Fundus photo. 1932x1916. 45° FOV: 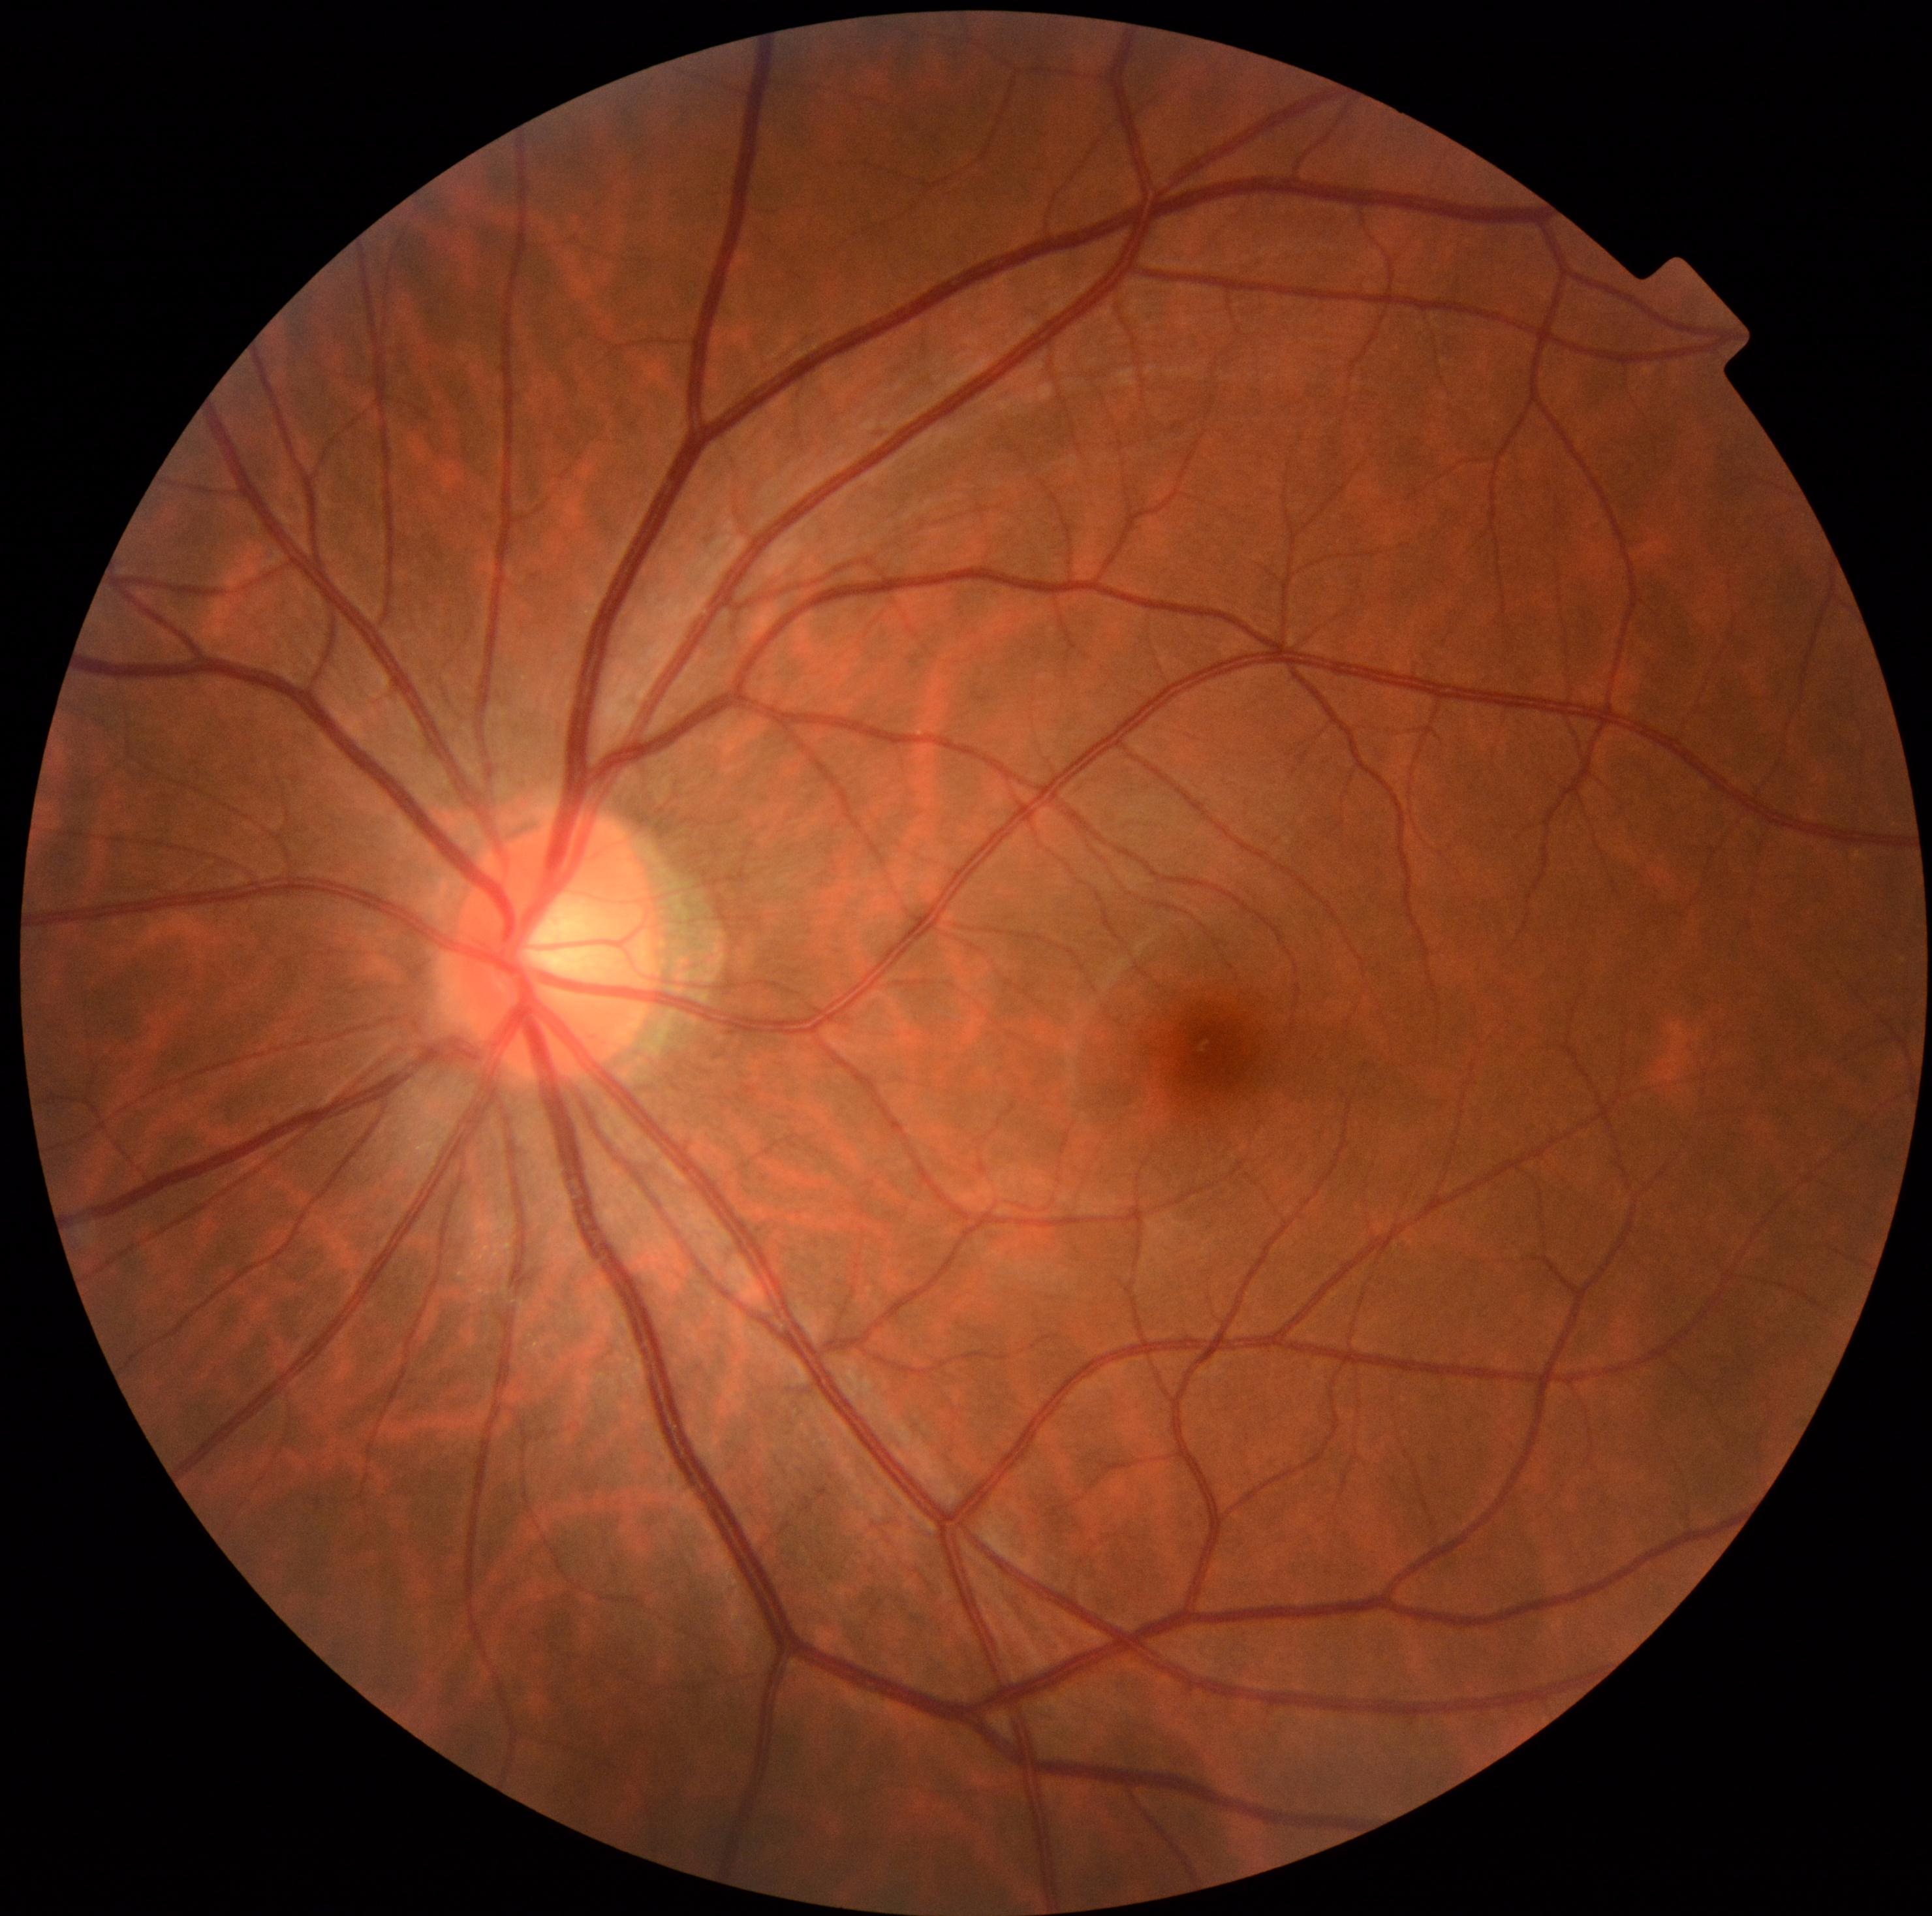 DR severity: no apparent retinopathy (grade 0).